Non-mydriatic acquisition: 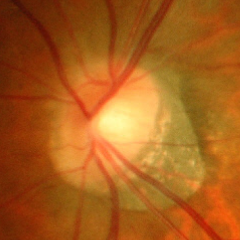 Q: What is the glaucoma diagnosis?
A: Advanced glaucoma.